Optic disc region of a color fundus photo · Topcon TRC retinal camera, IMAGEnet capture system:
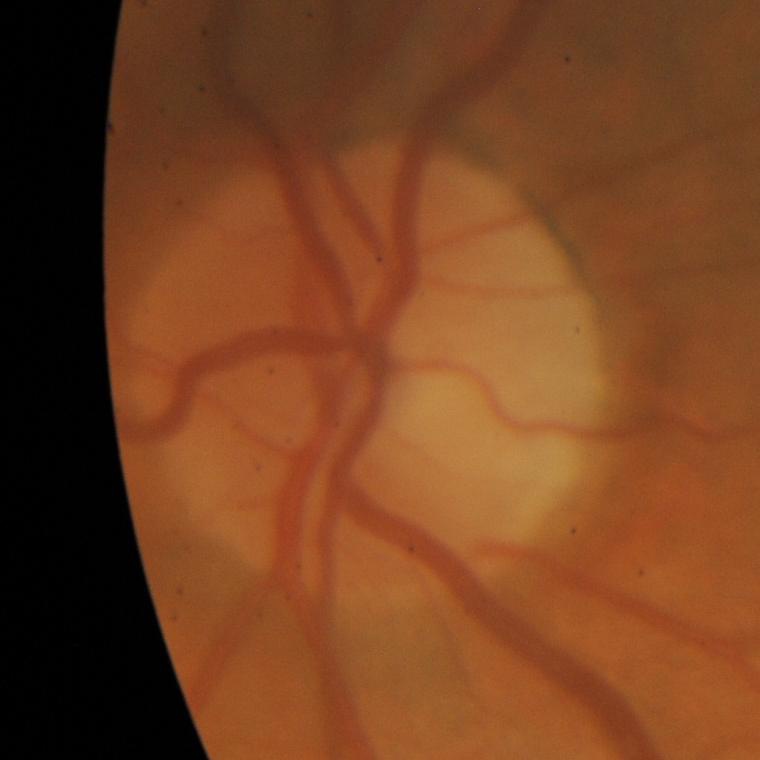 Demonstrates glaucomatous findings.